1932x1932 — 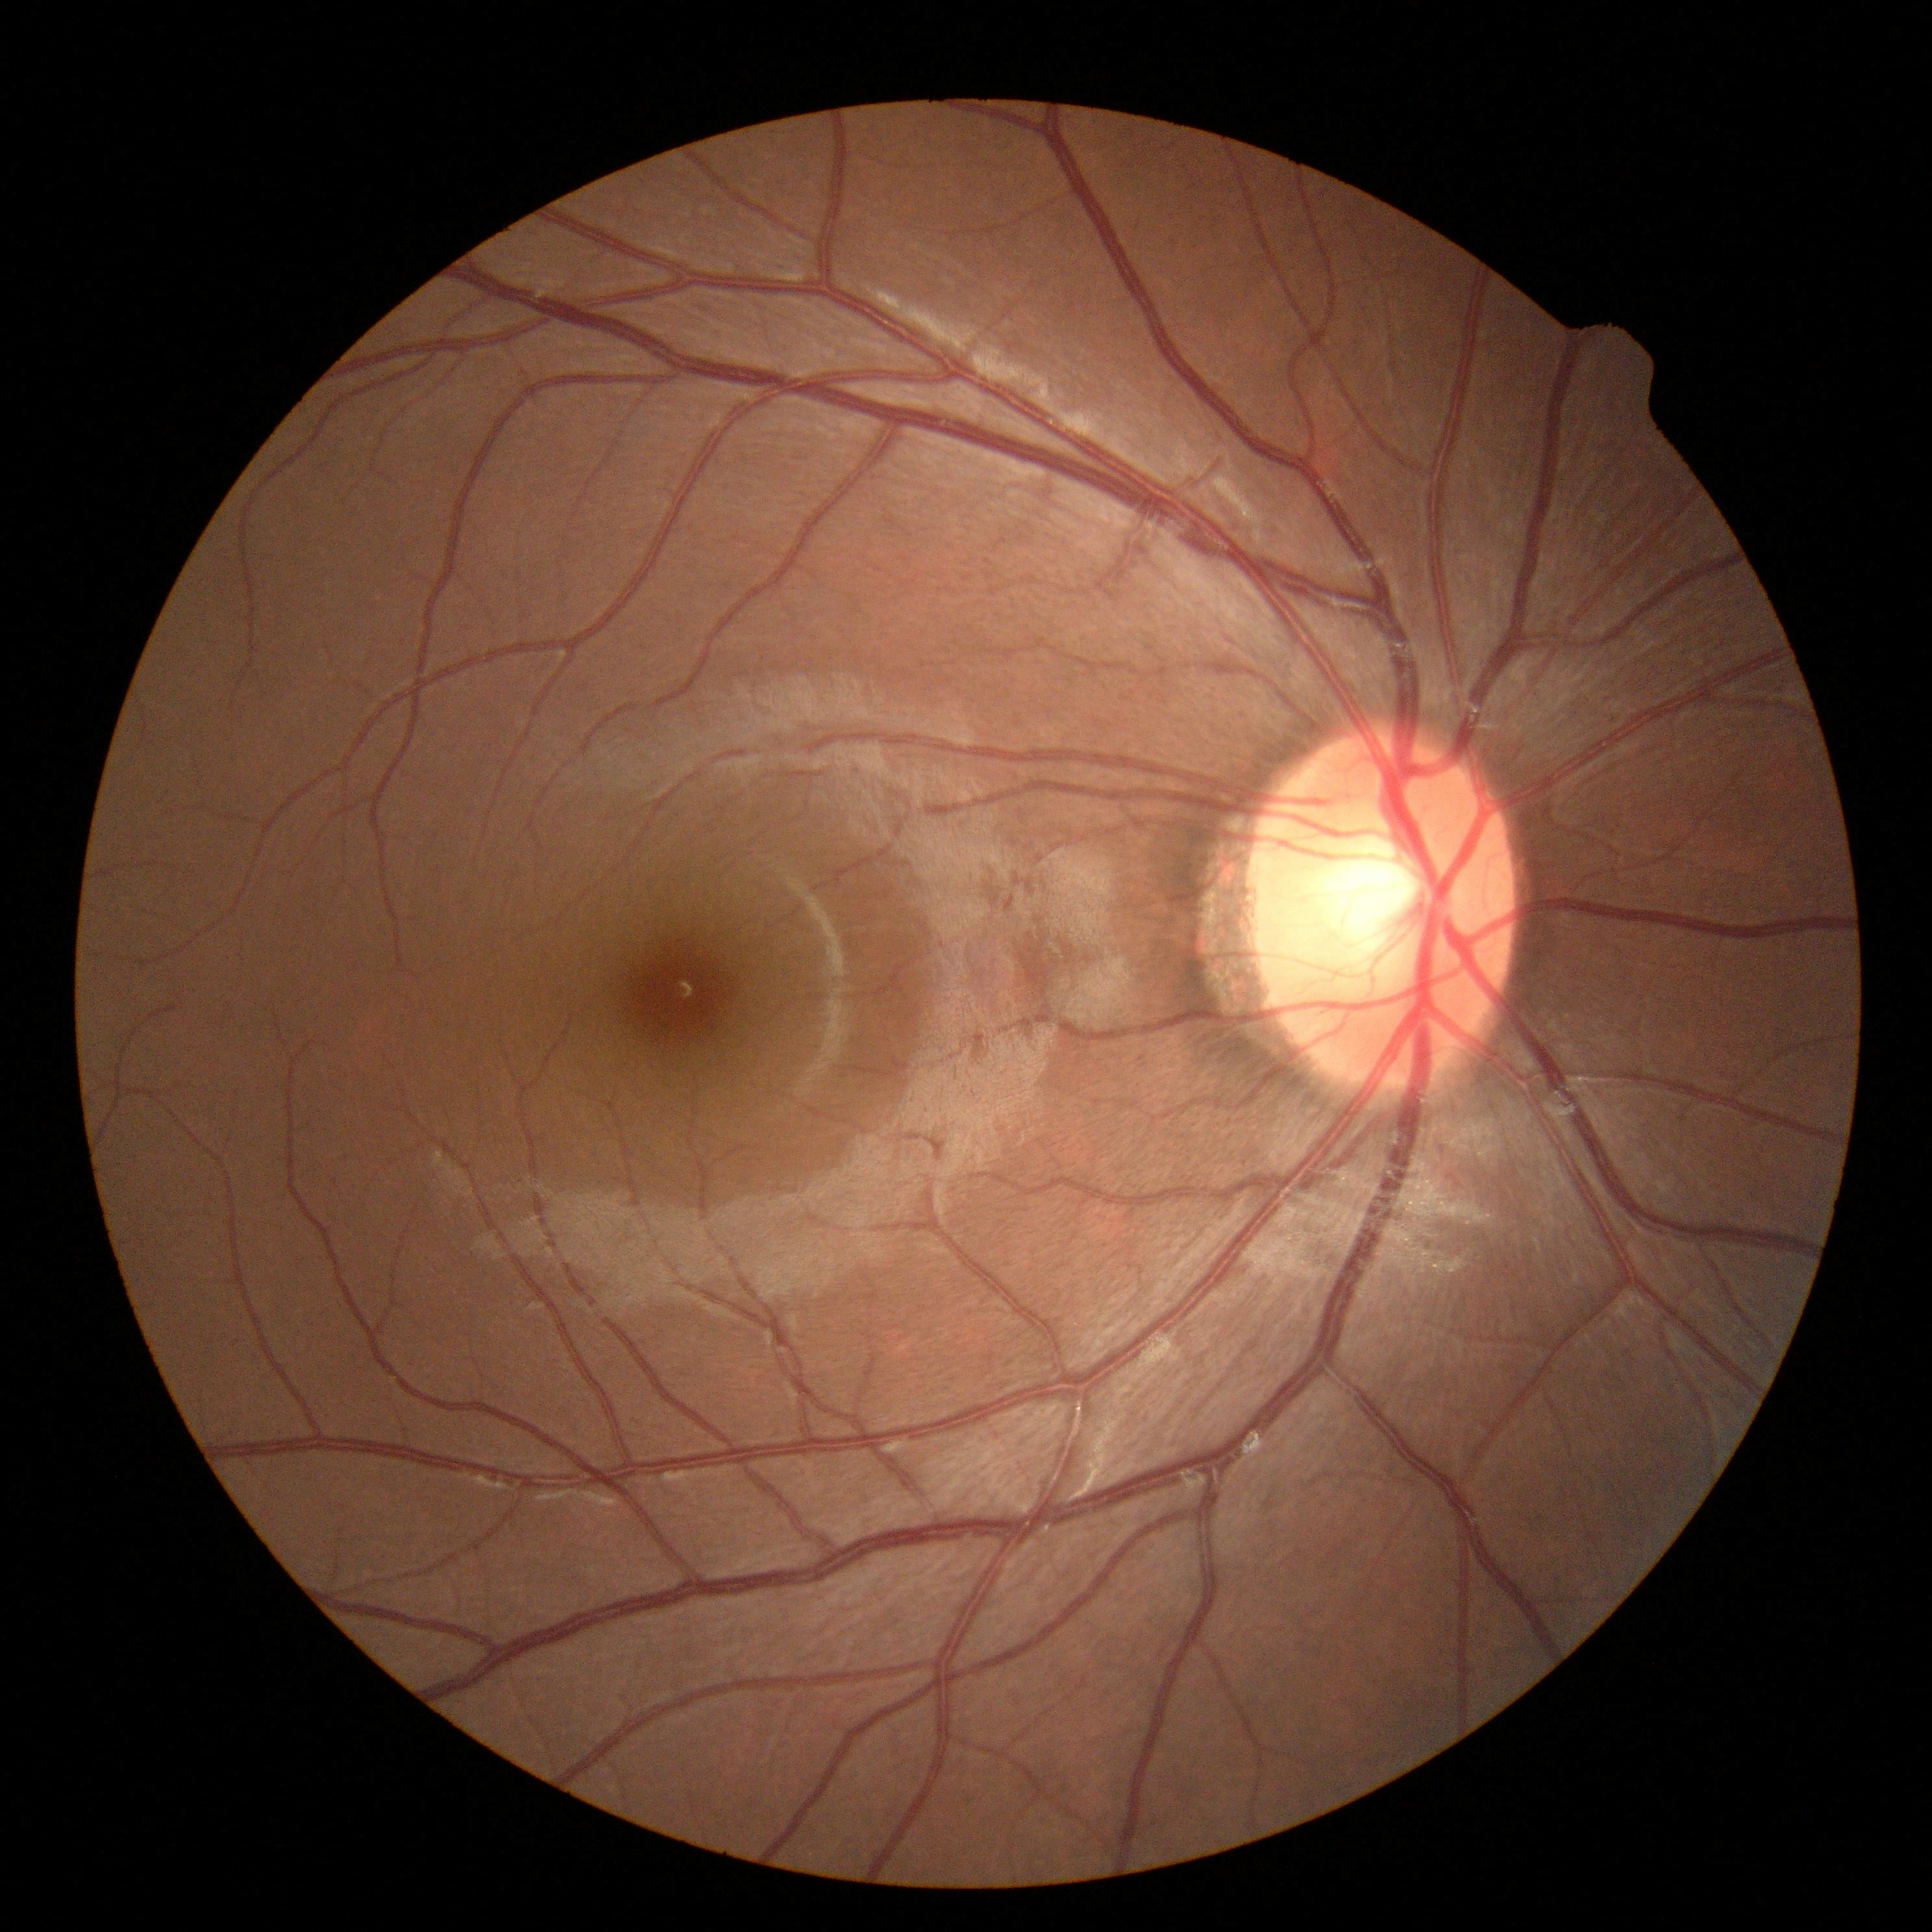 Diabetic retinopathy (DR): grade 0 (no apparent retinopathy) — no visible signs of diabetic retinopathy.